Davis DR grading. Acquired with a NIDEK AFC-230. FOV: 45 degrees.
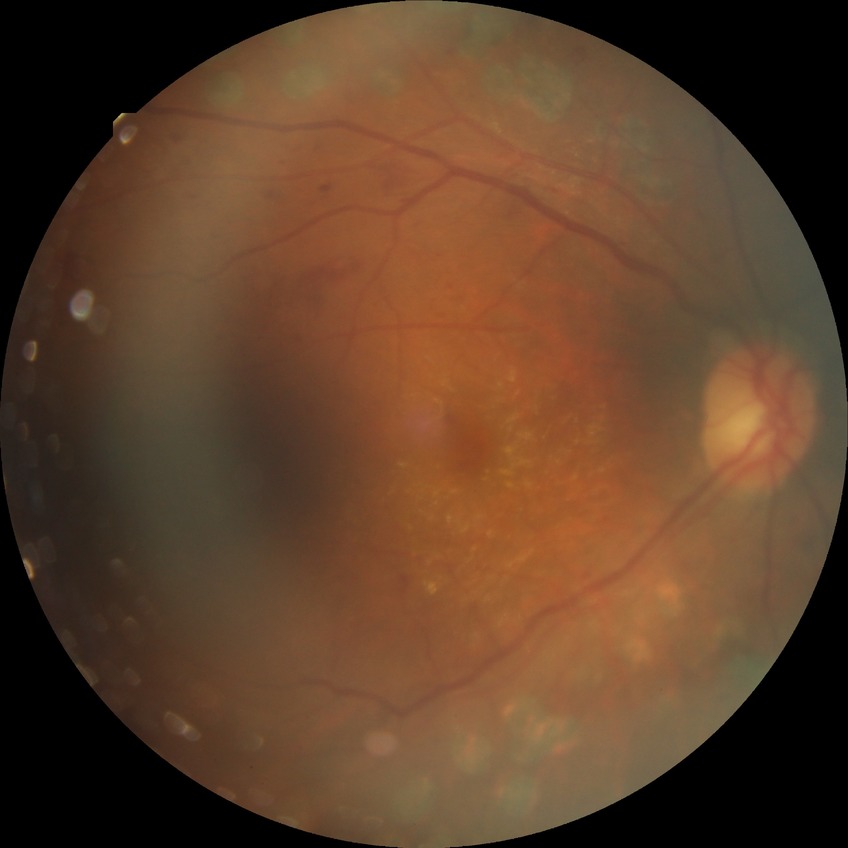 Davis stage is PDR.